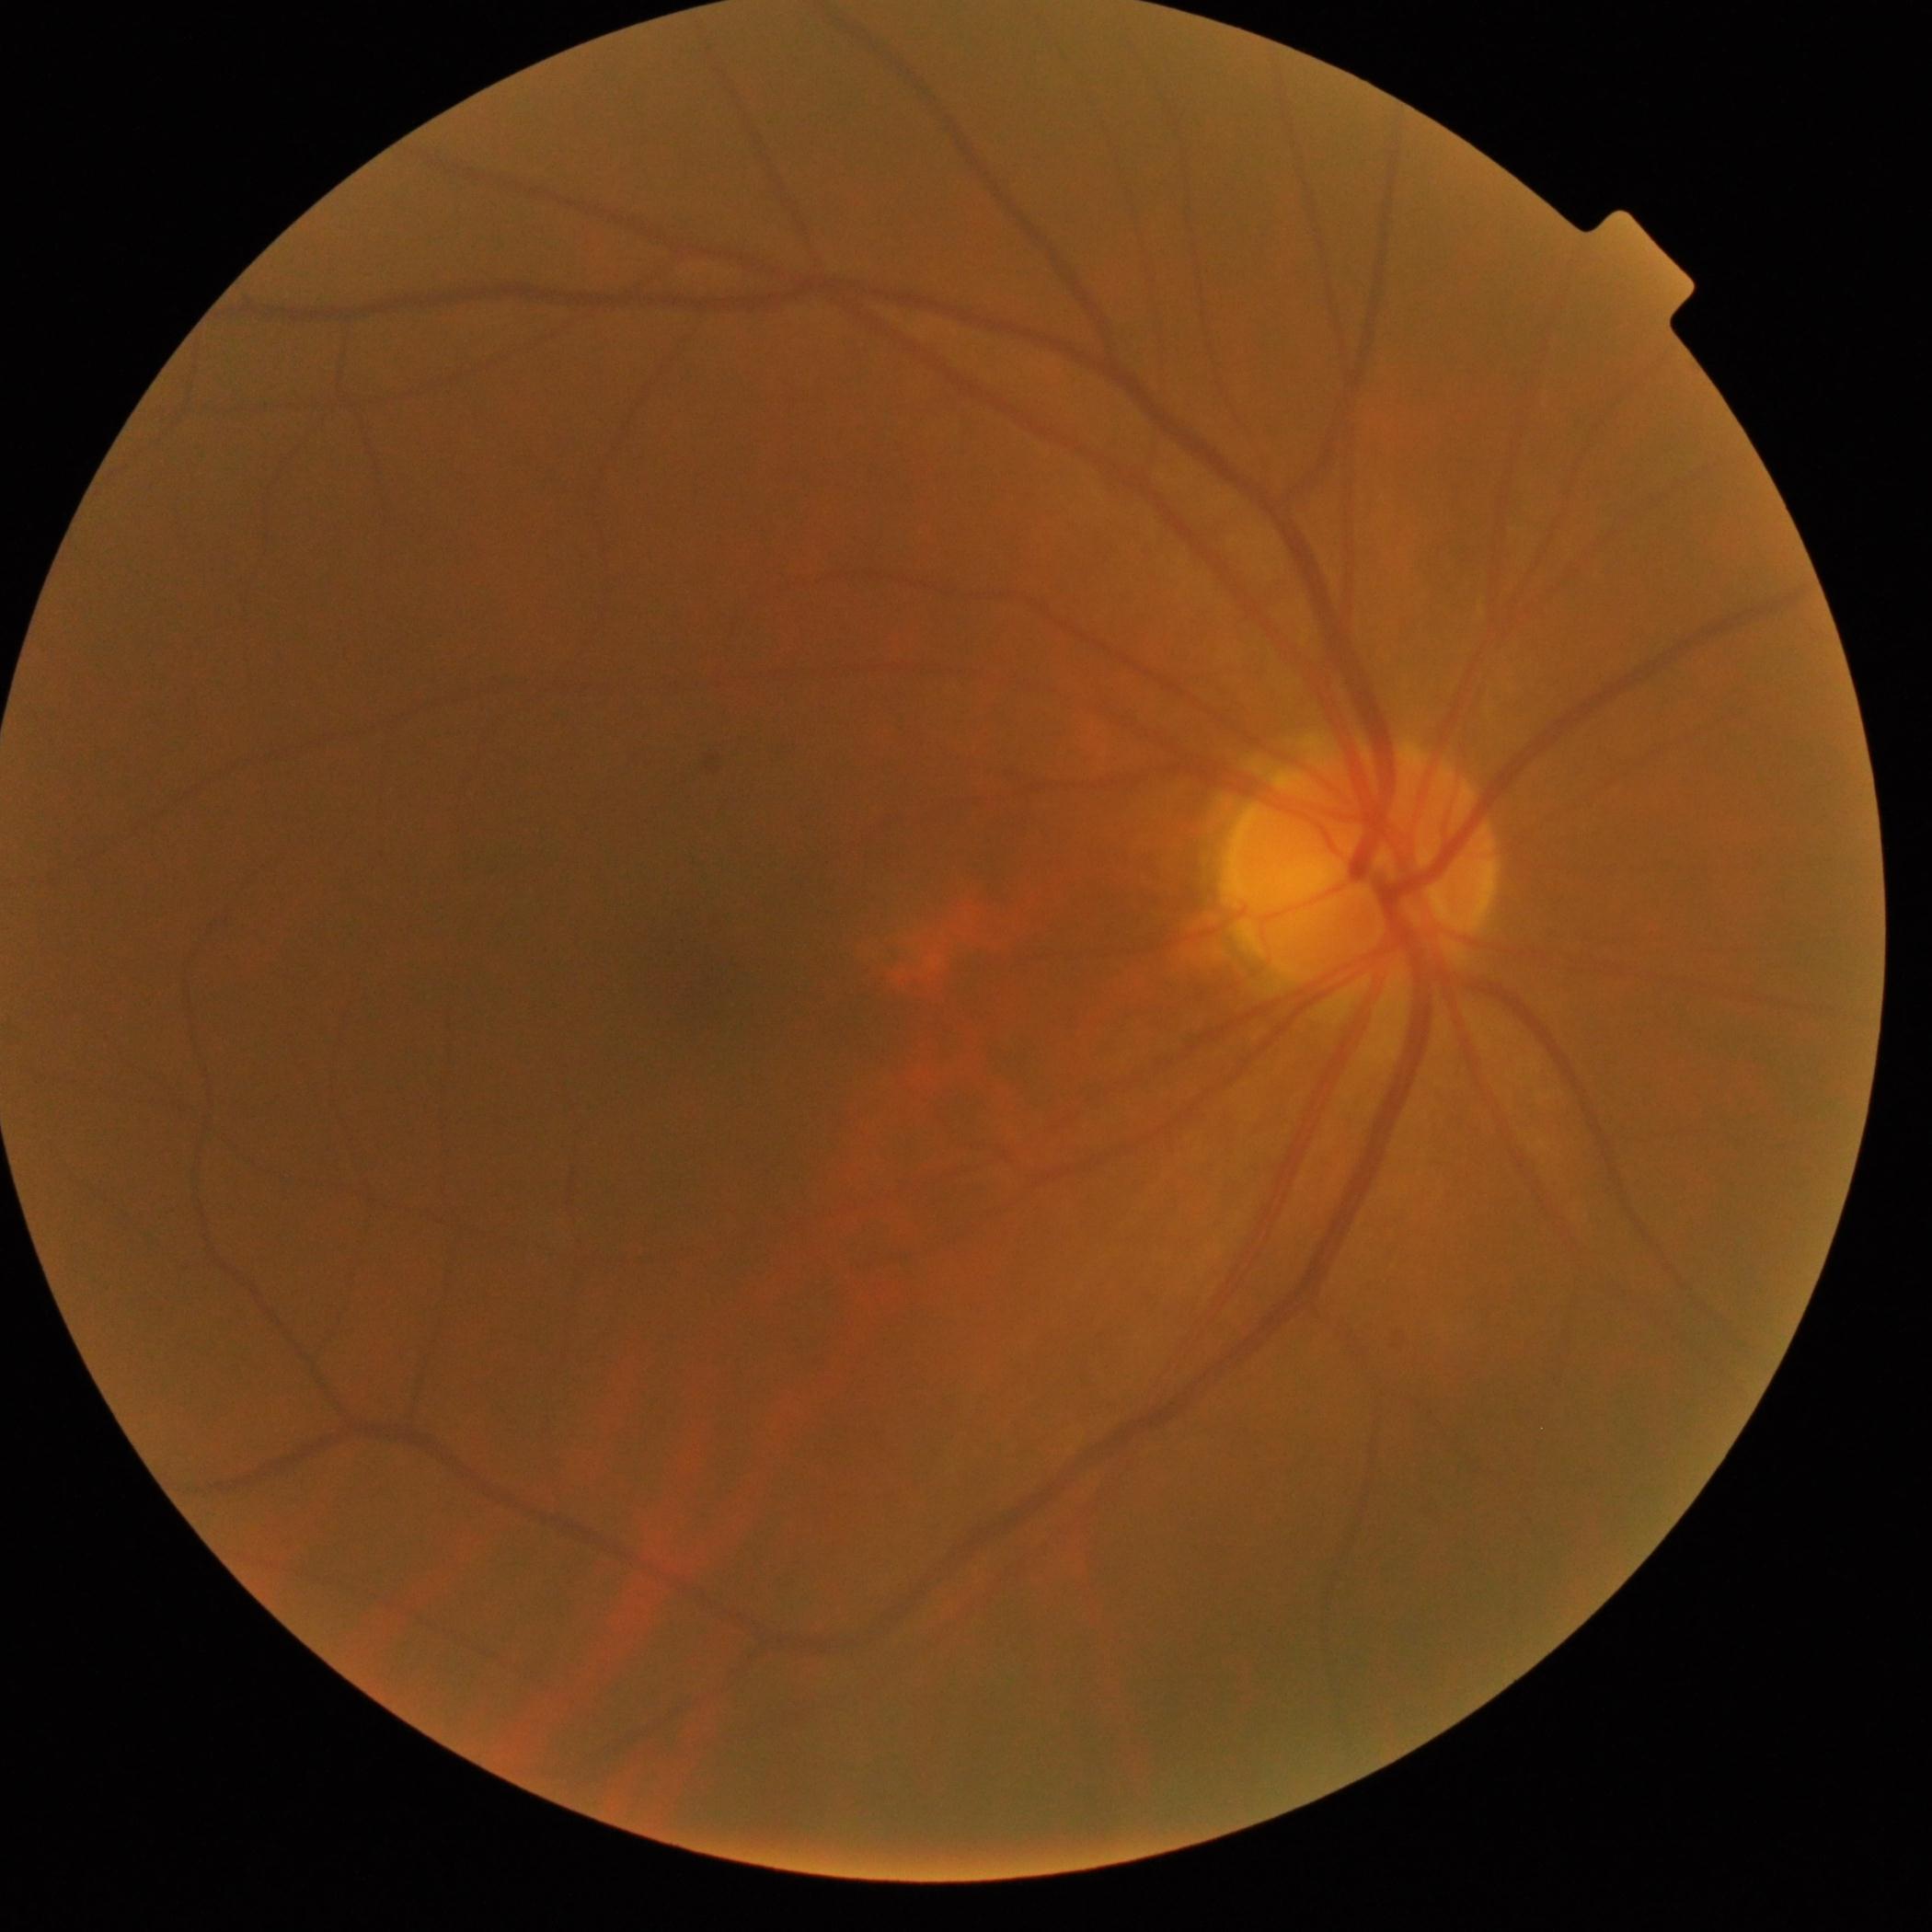 No DR findings.
Diabetic retinopathy (DR) is grade 0 (no apparent retinopathy).